Camera: NIDEK AFC-230: 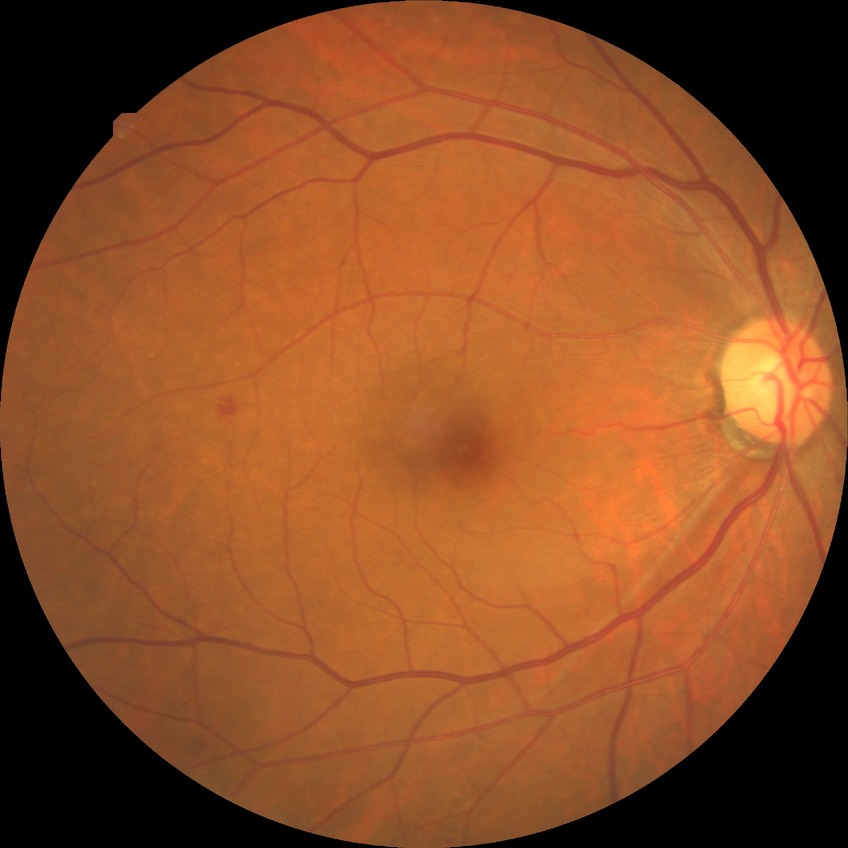

Diabetic retinopathy (DR) is simple diabetic retinopathy (SDR).